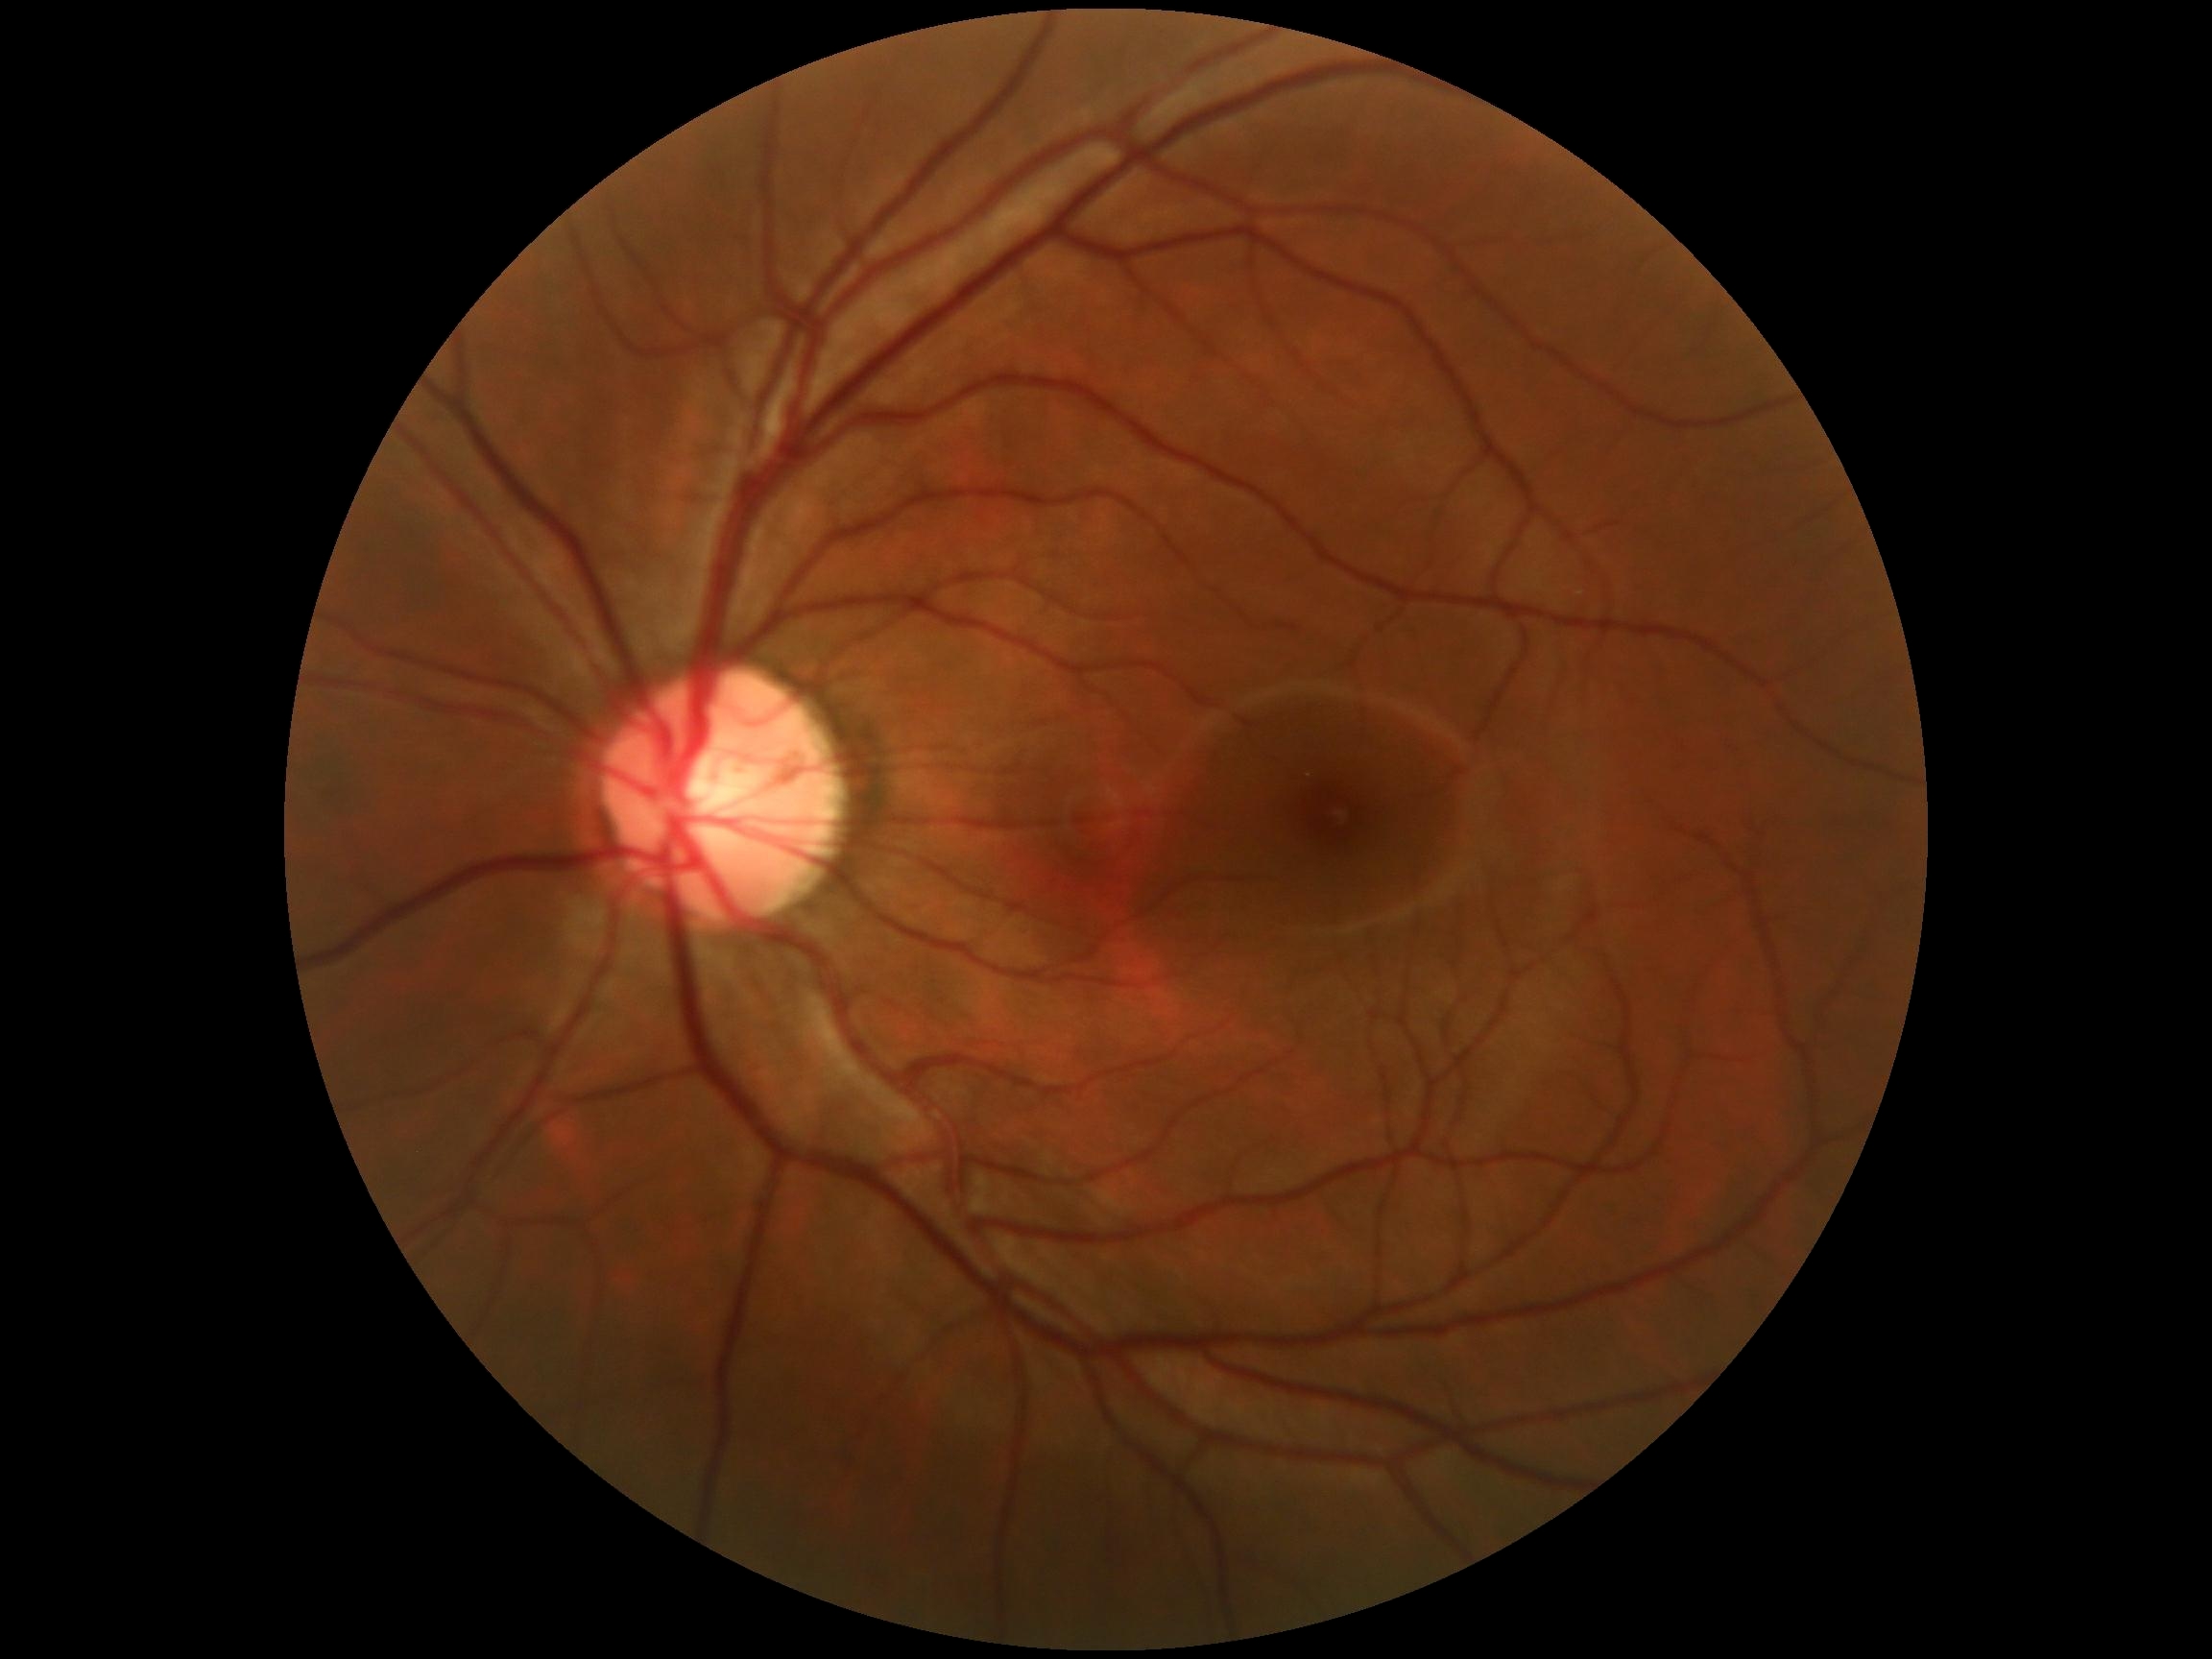 DR stage is 0/4.